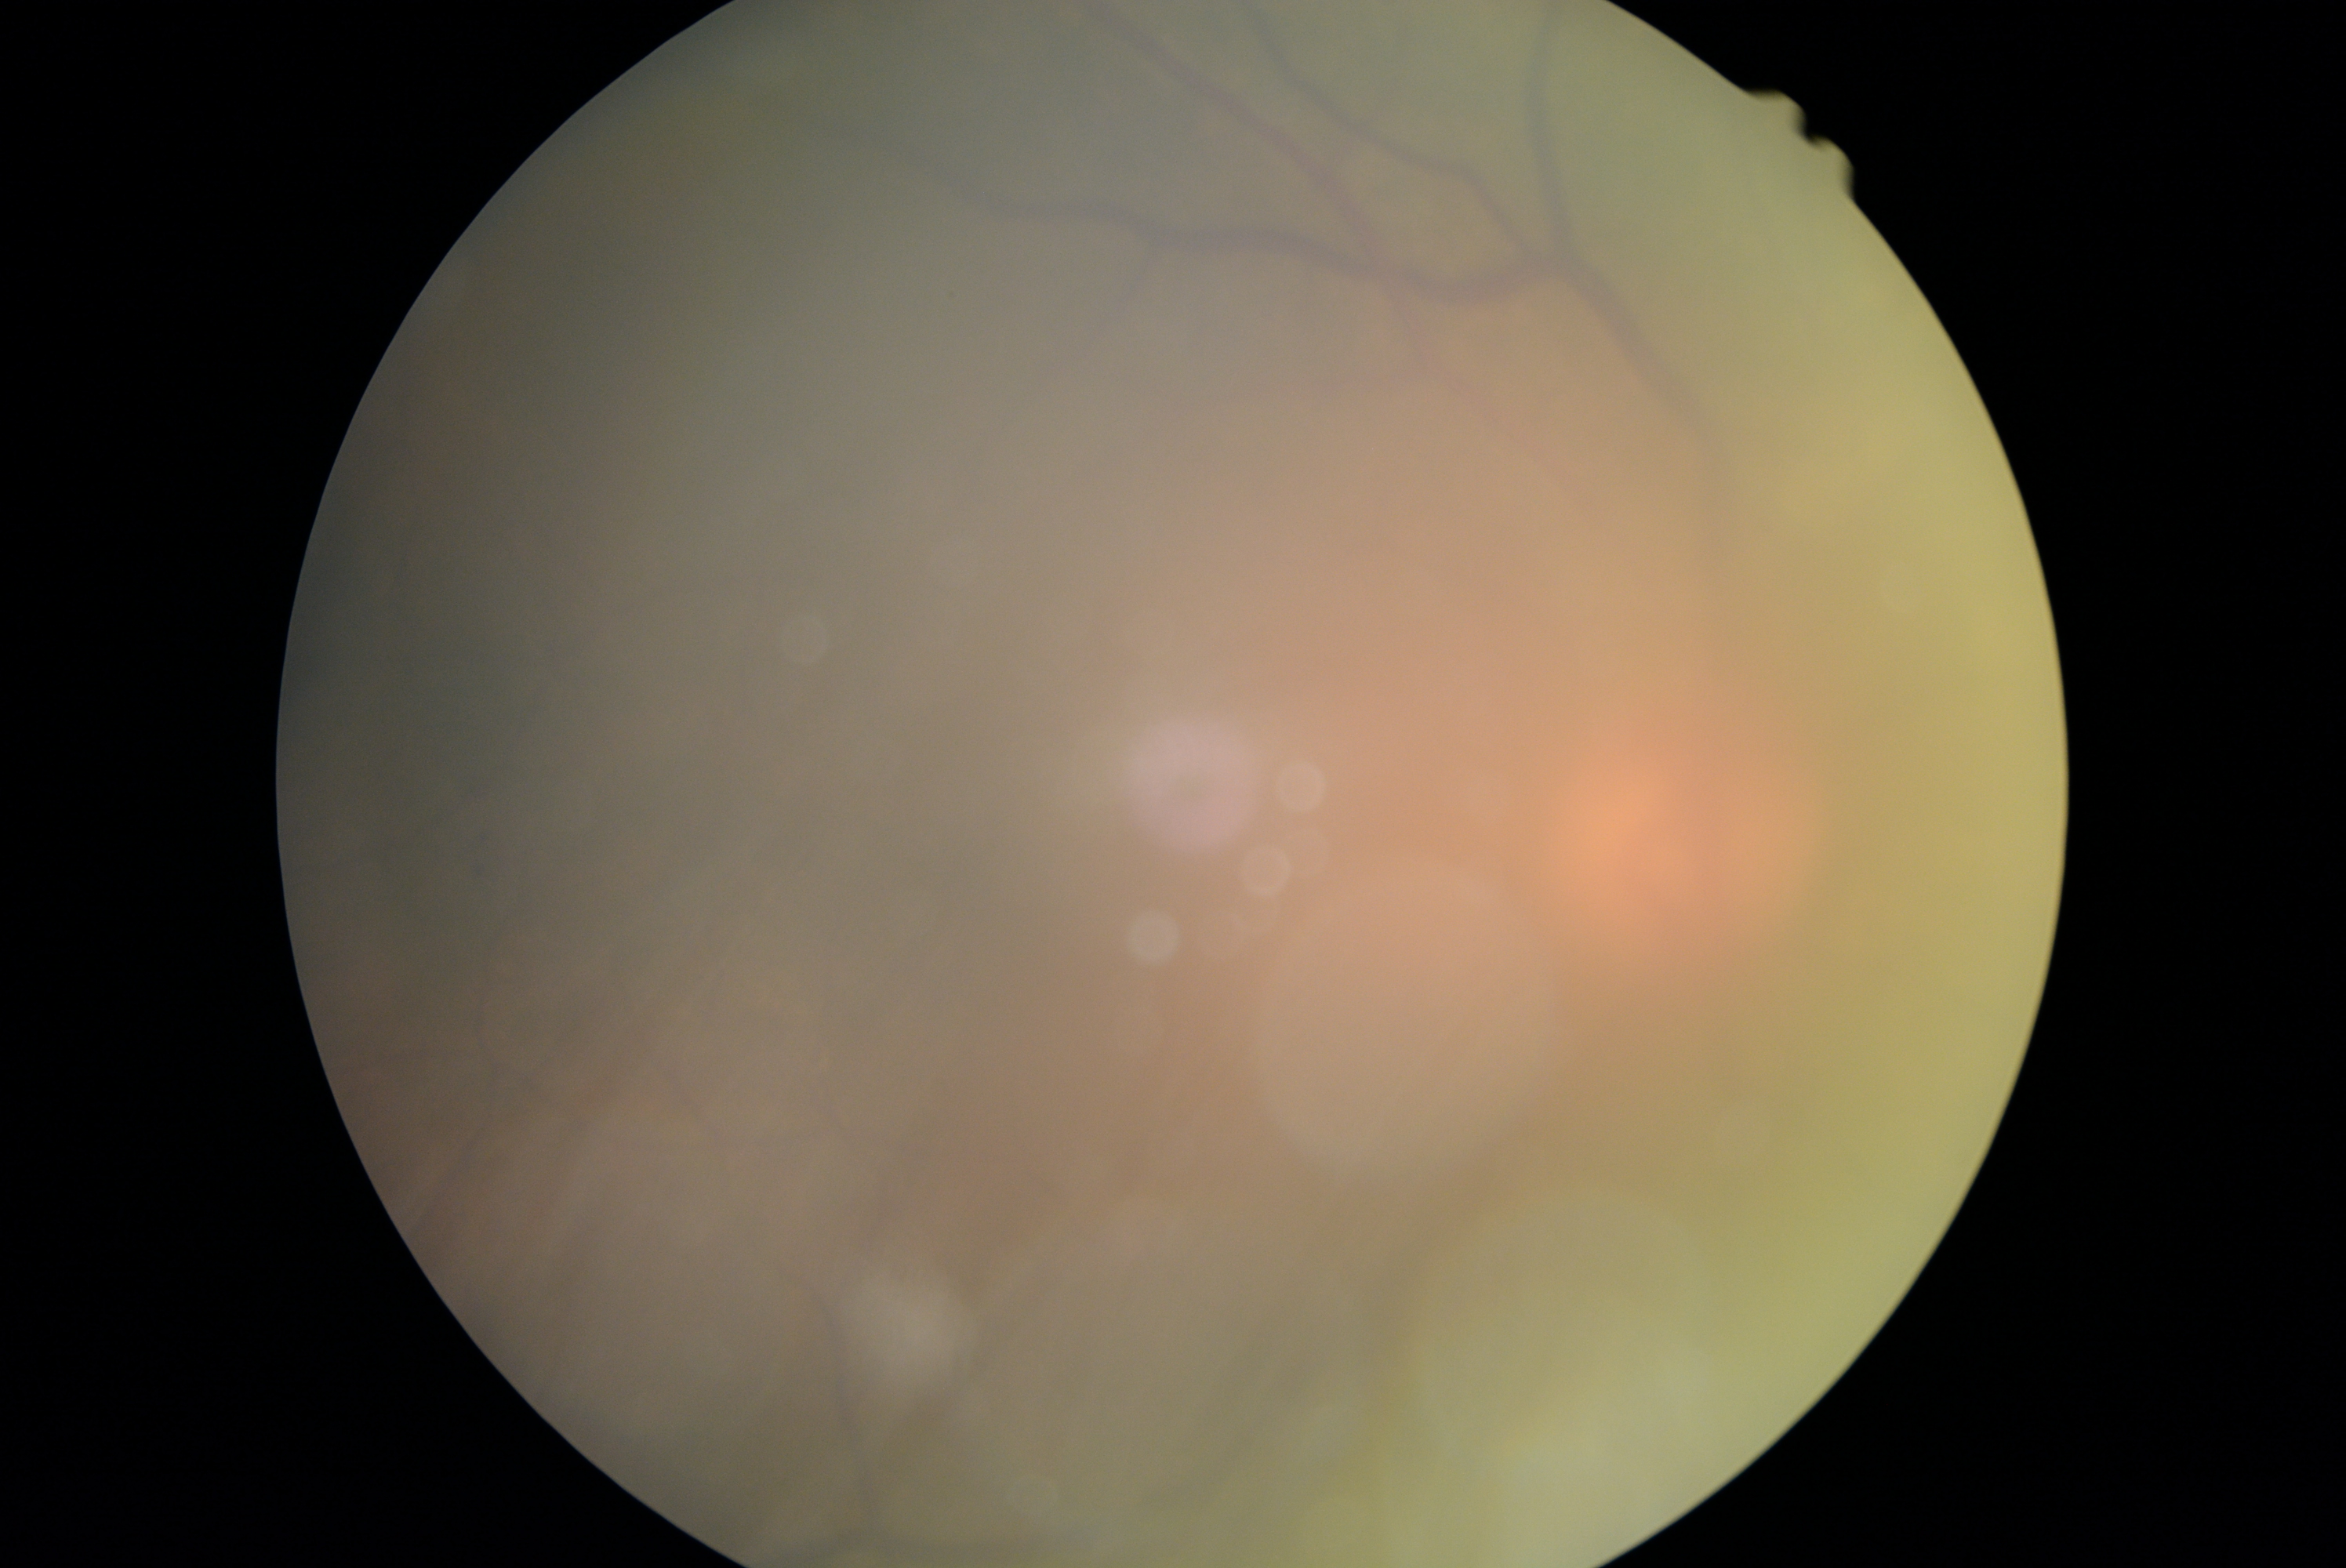
Retinopathy: ungradable. The image cannot be graded for diabetic retinopathy.